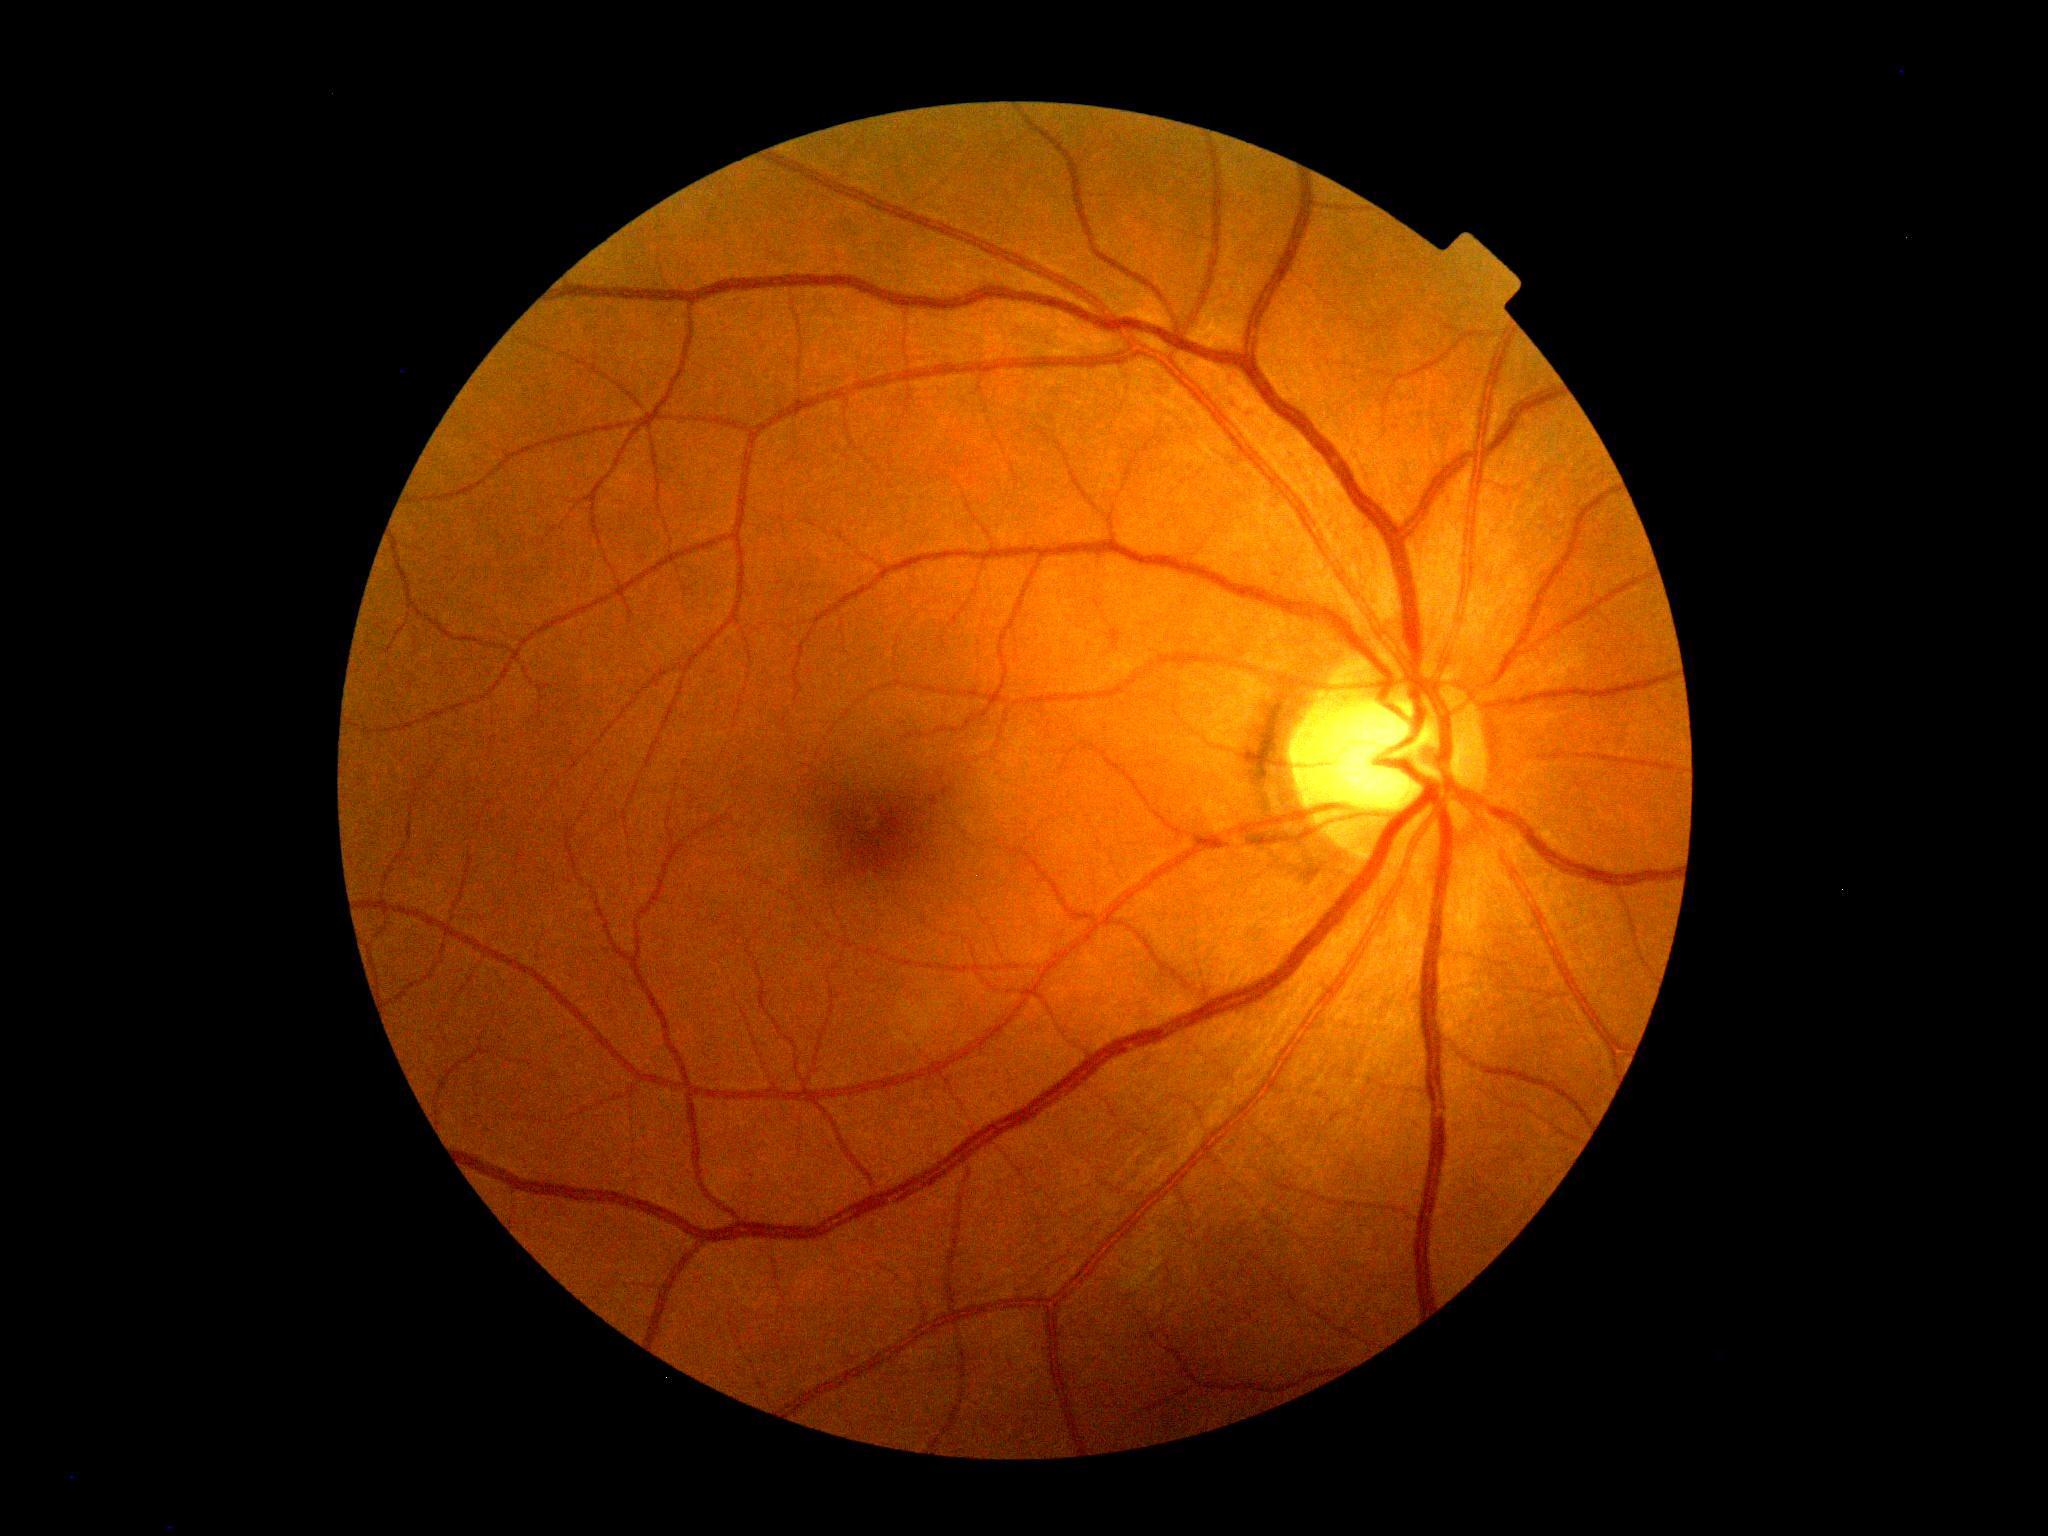

No diabetic retinal disease findings. DR stage is grade 0 (no apparent retinopathy).